45° FOV
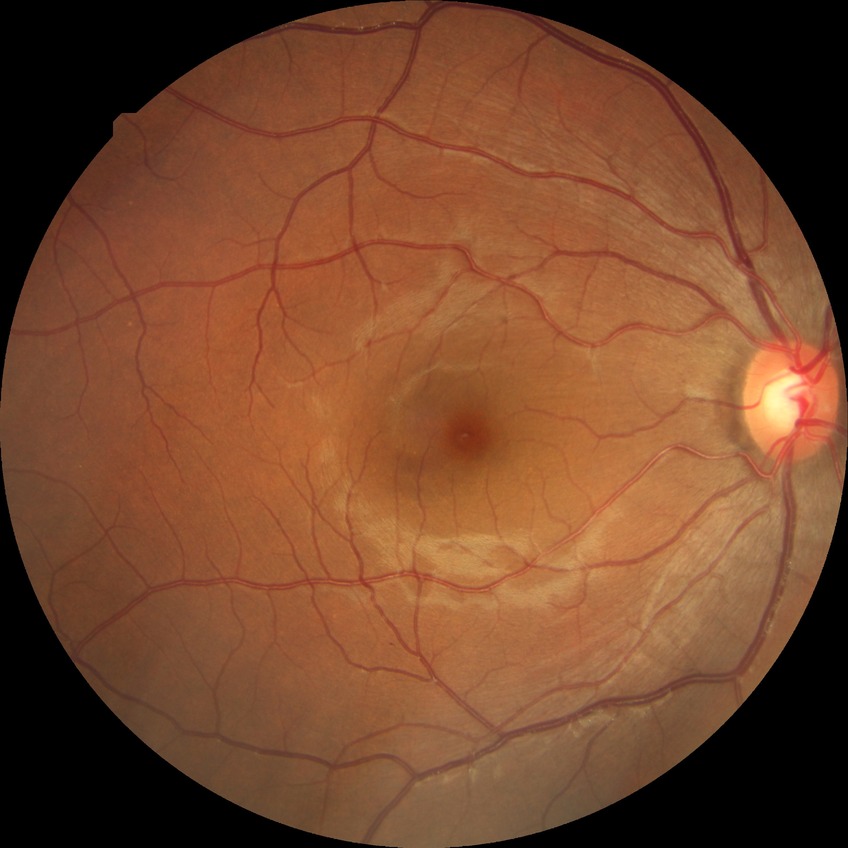

Modified Davis classification is no diabetic retinopathy.